Camera: Remidio smartphone fundus camera
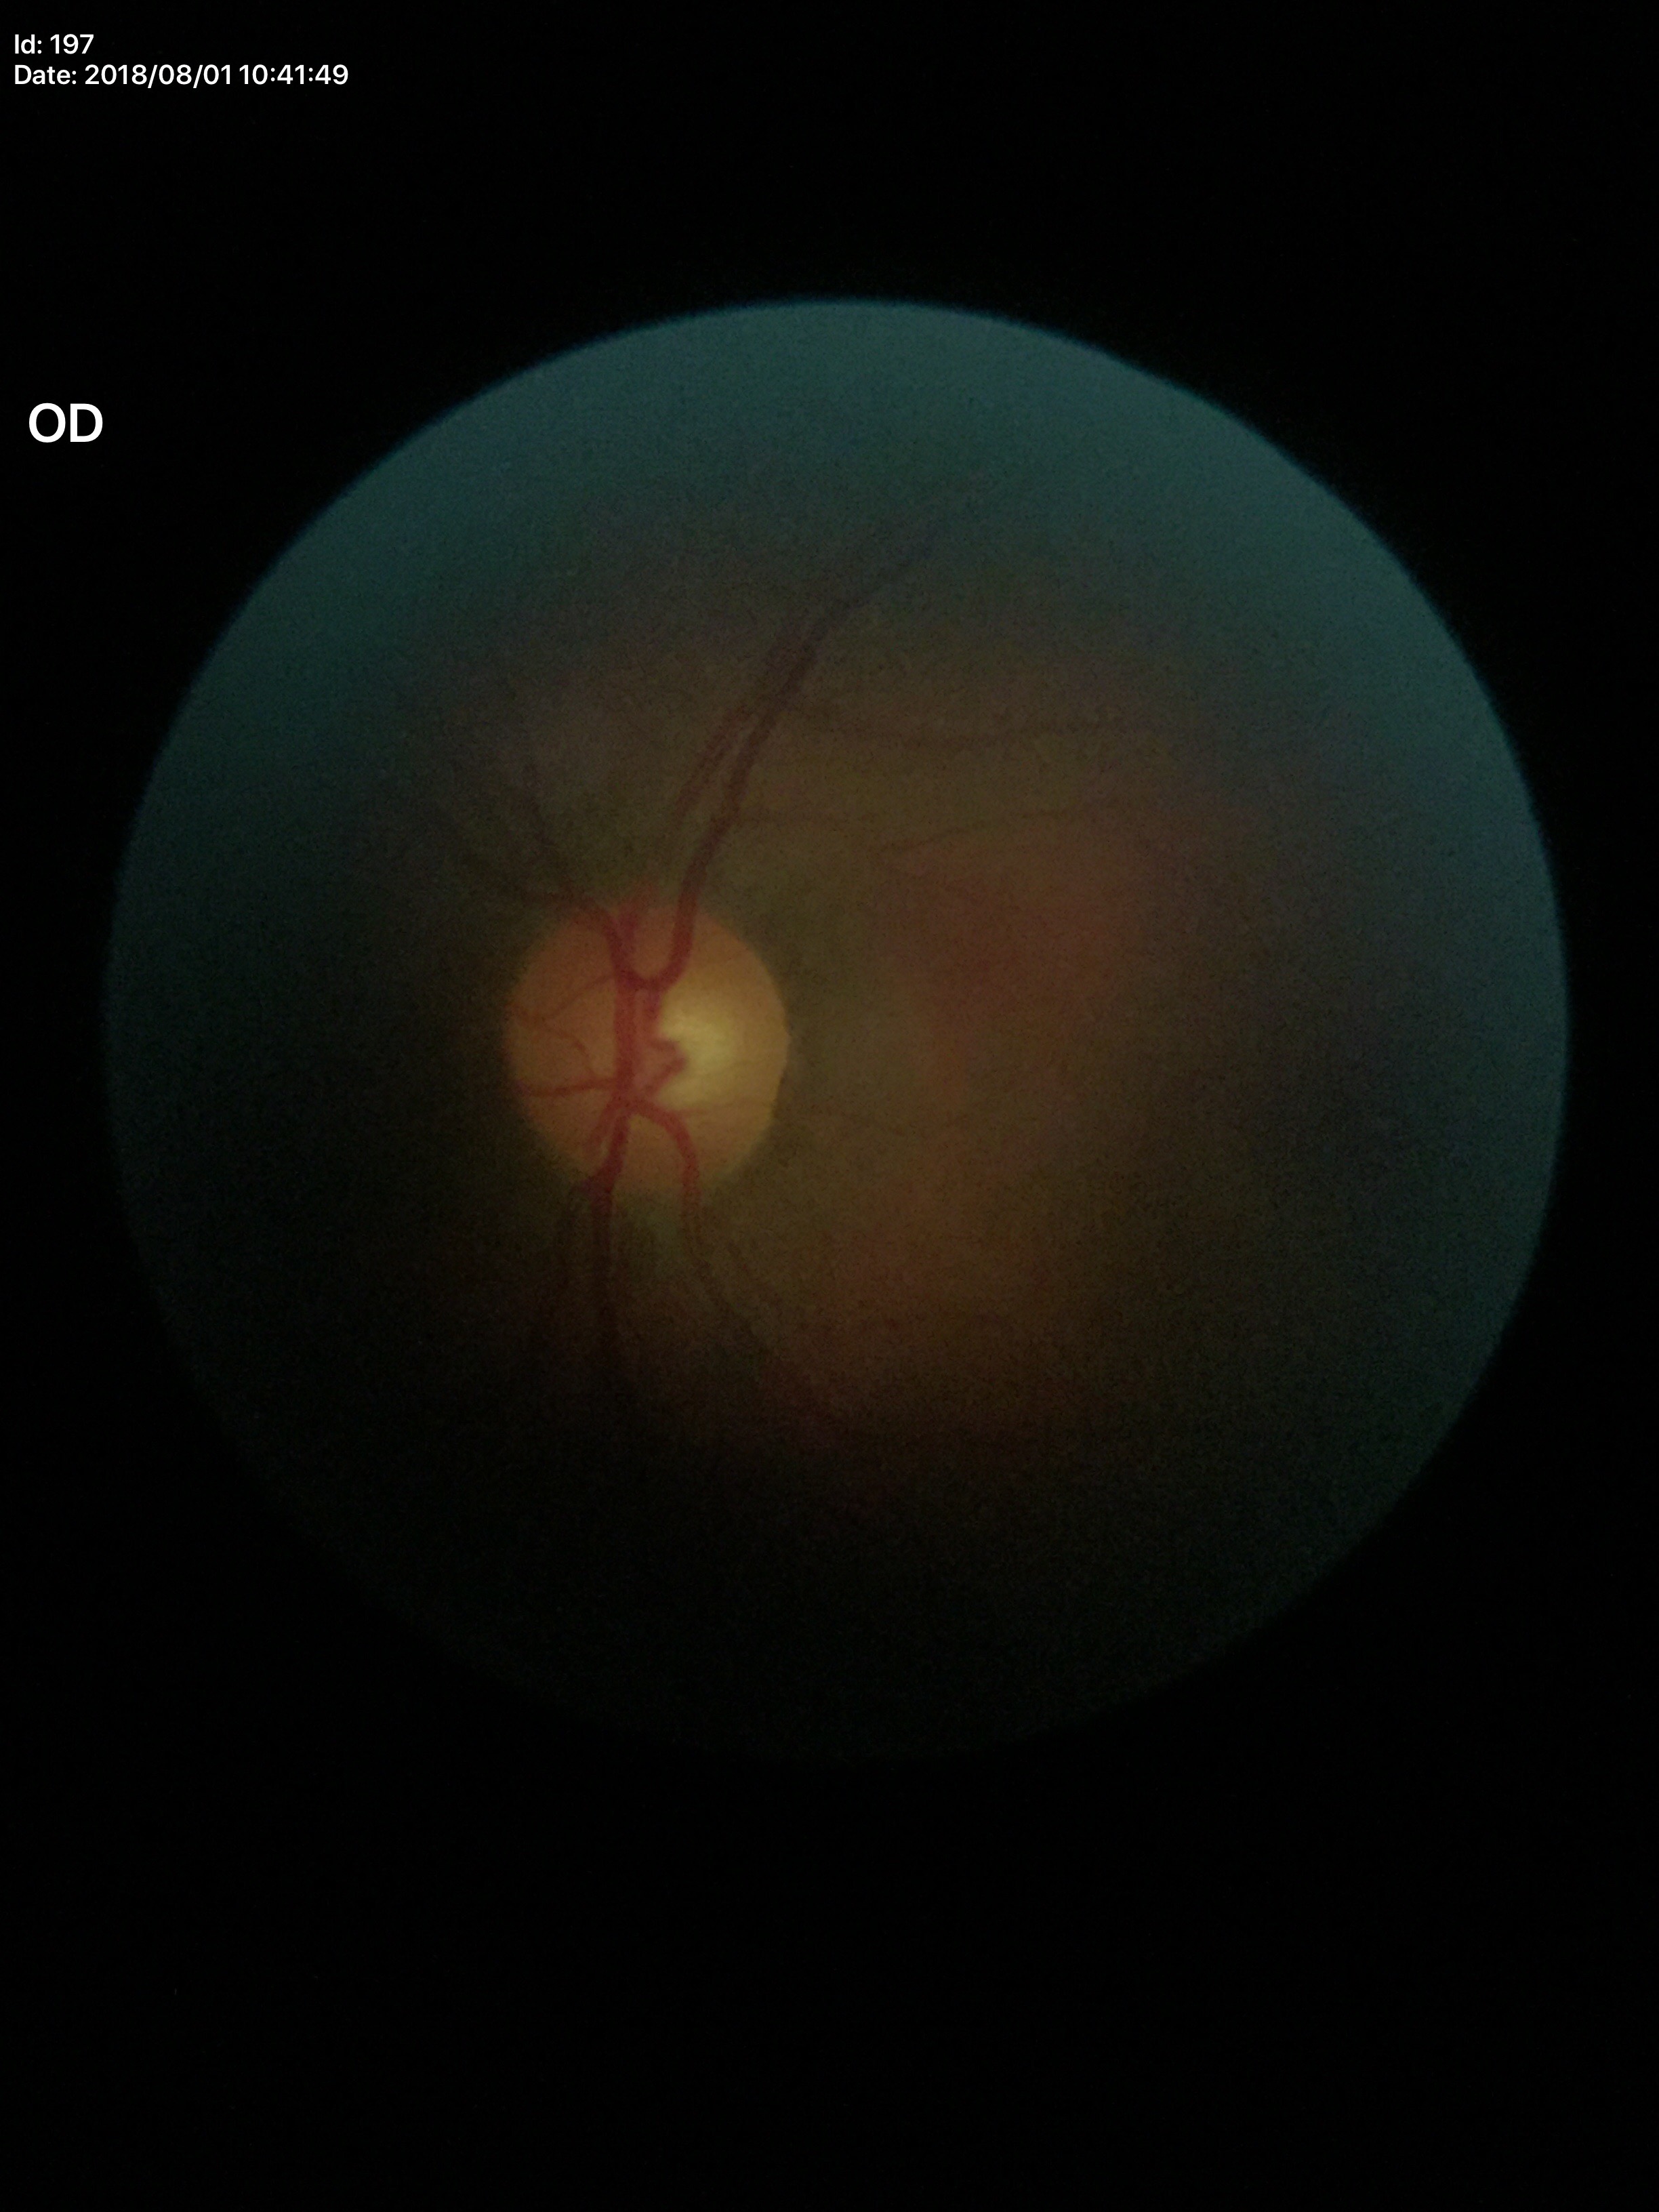

Horizontal cup-to-disc ratio (HCDR): 0.53.
No glaucomatous findings.
Vertical C/D ratio (VCDR) is 0.48.